1536x1152px.
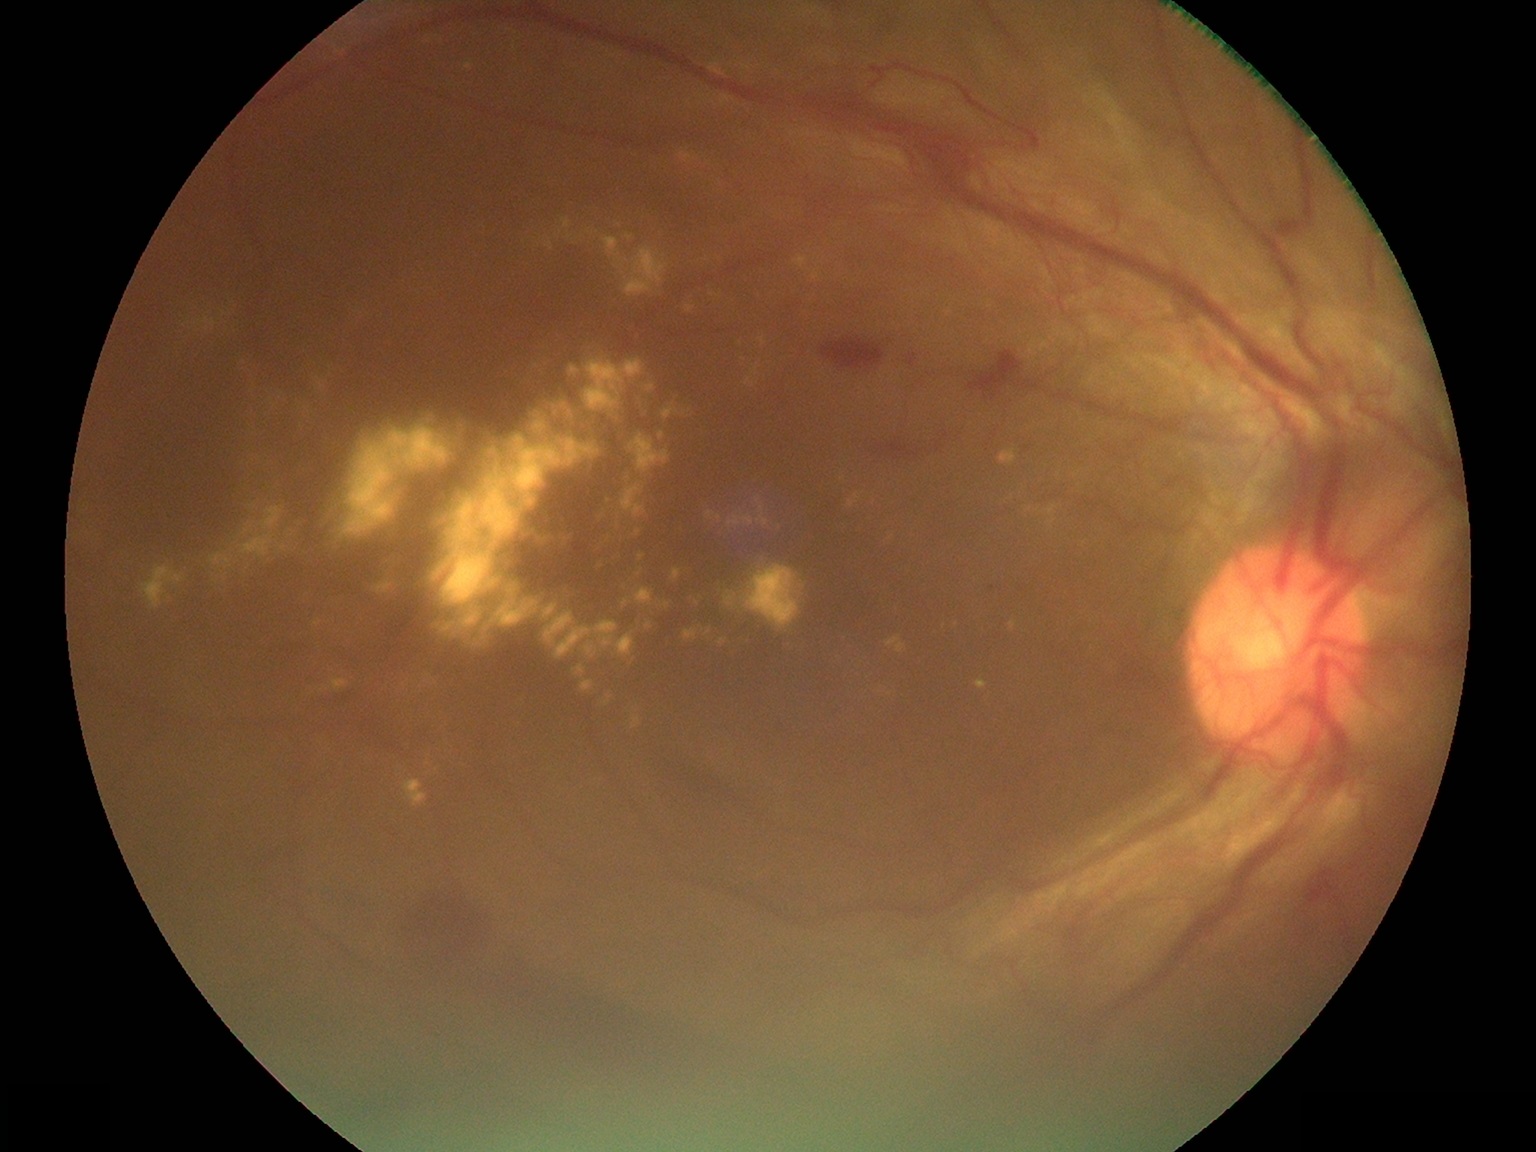
Diabetic retinopathy severity is proliferative diabetic retinopathy (grade 4); proliferative diabetic retinopathy
Lesions identified (partial list):
hard exudates (continued): (402, 779, 428, 808); (706, 511, 721, 520); (210, 553, 234, 570); (741, 566, 805, 630); (610, 416, 621, 421); (709, 60, 728, 76); (684, 629, 699, 643); (639, 553, 646, 562); (629, 658, 637, 663); (313, 619, 322, 628); (614, 513, 622, 535); (604, 695, 613, 706); (575, 665, 585, 676)
Additional small hard exudates near x=426 y=682; x=890 y=694; x=169 y=598; x=577 y=238; x=522 y=700